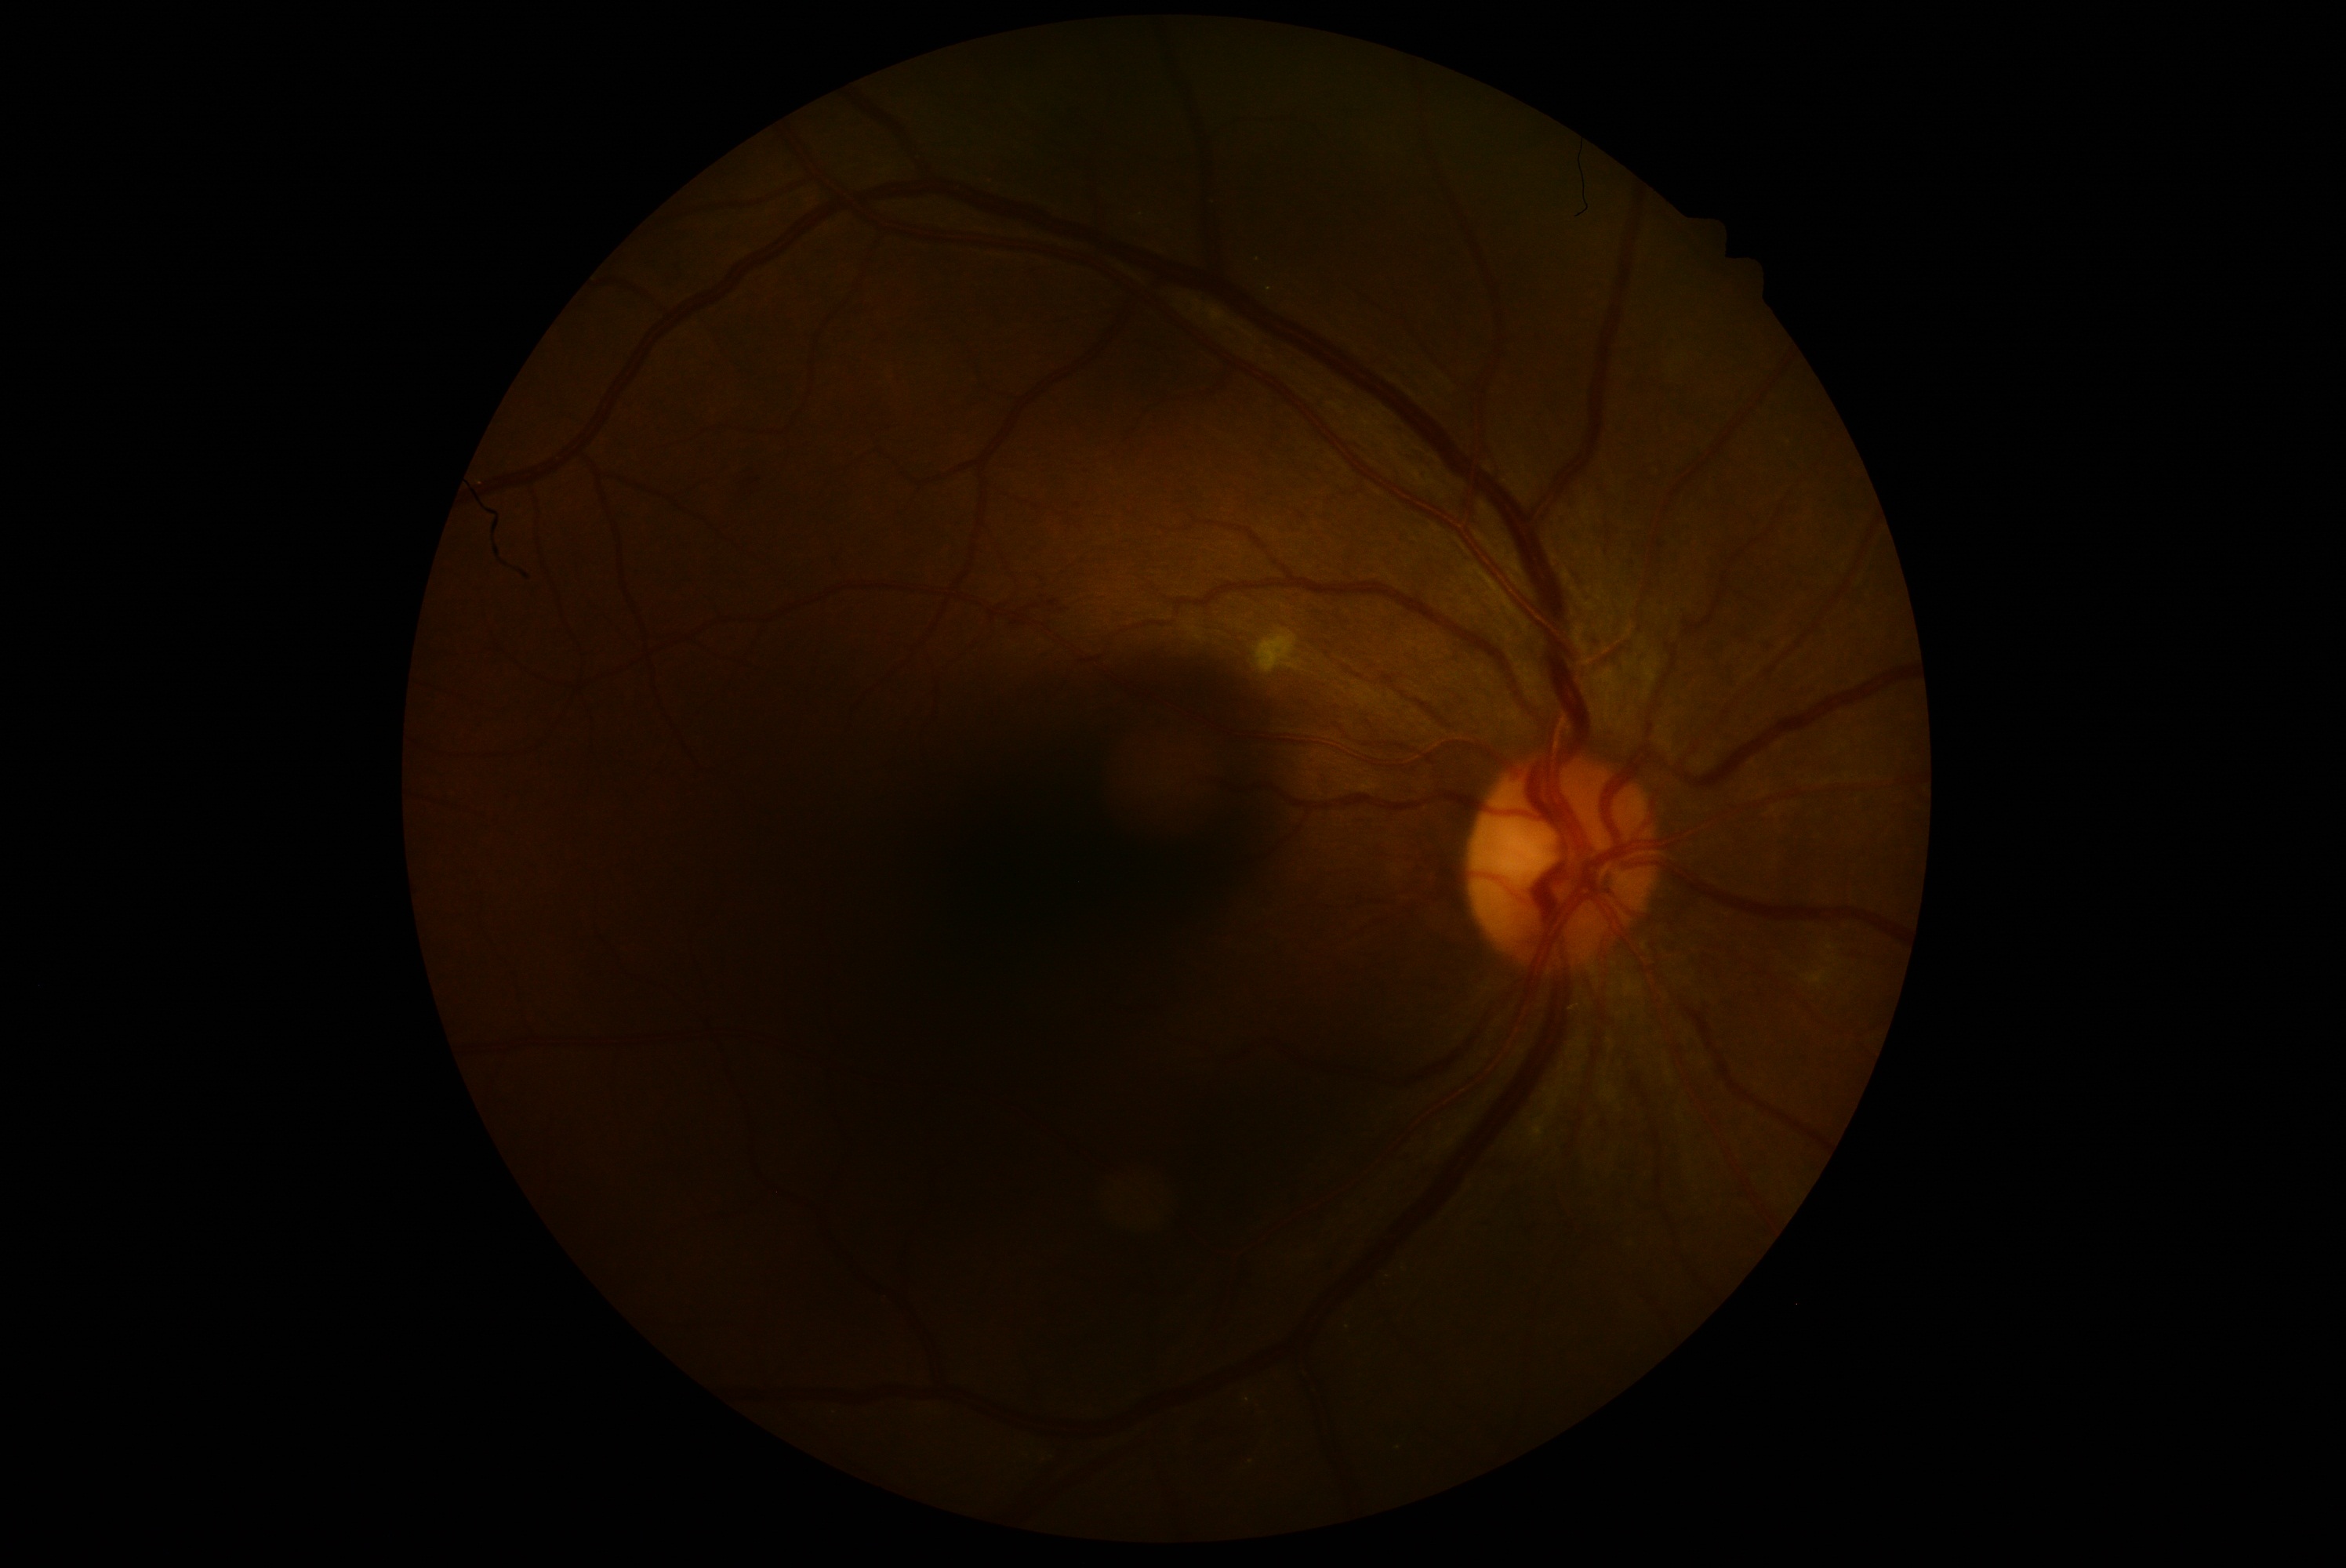
DR class: non-proliferative diabetic retinopathy. Diabetic retinopathy (DR) is grade 2 (moderate NPDR).